FOV: 45 degrees, retinal fundus photograph.
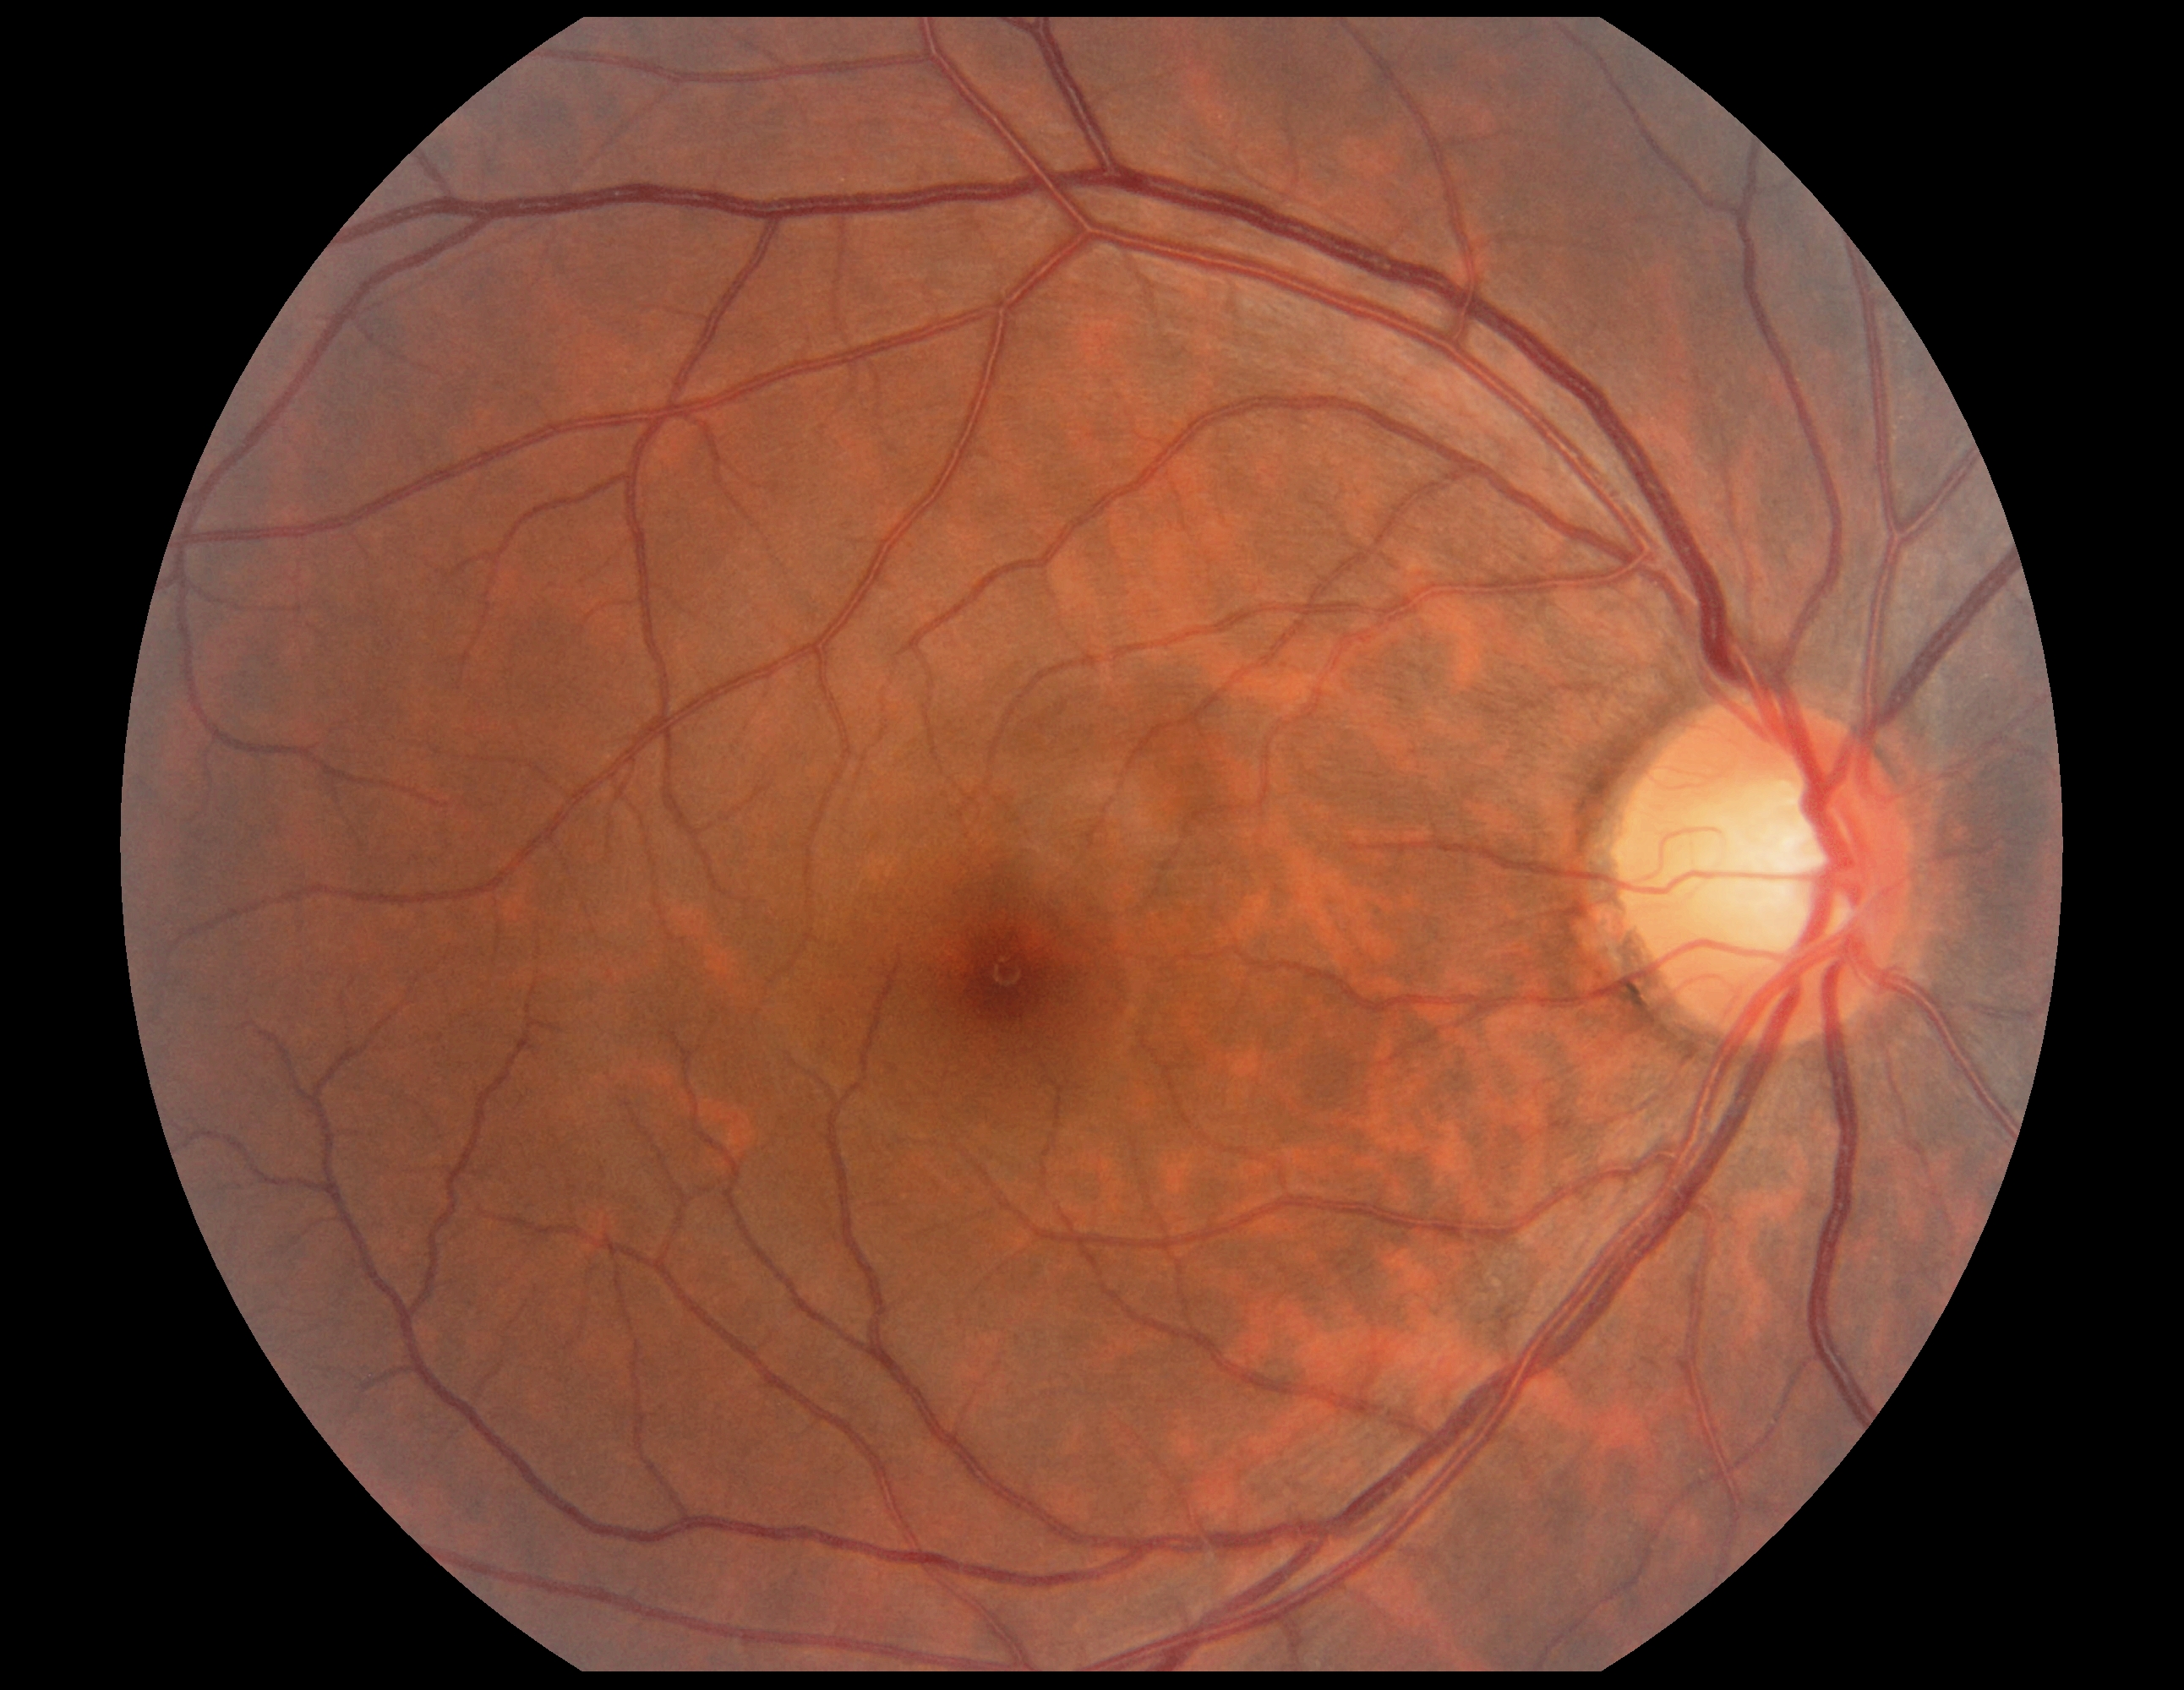

DR: 0/4, DR impression: no DR findings.